Pediatric retinal photograph (wide-field) · 1240x1240 · 100° field of view (Phoenix ICON)
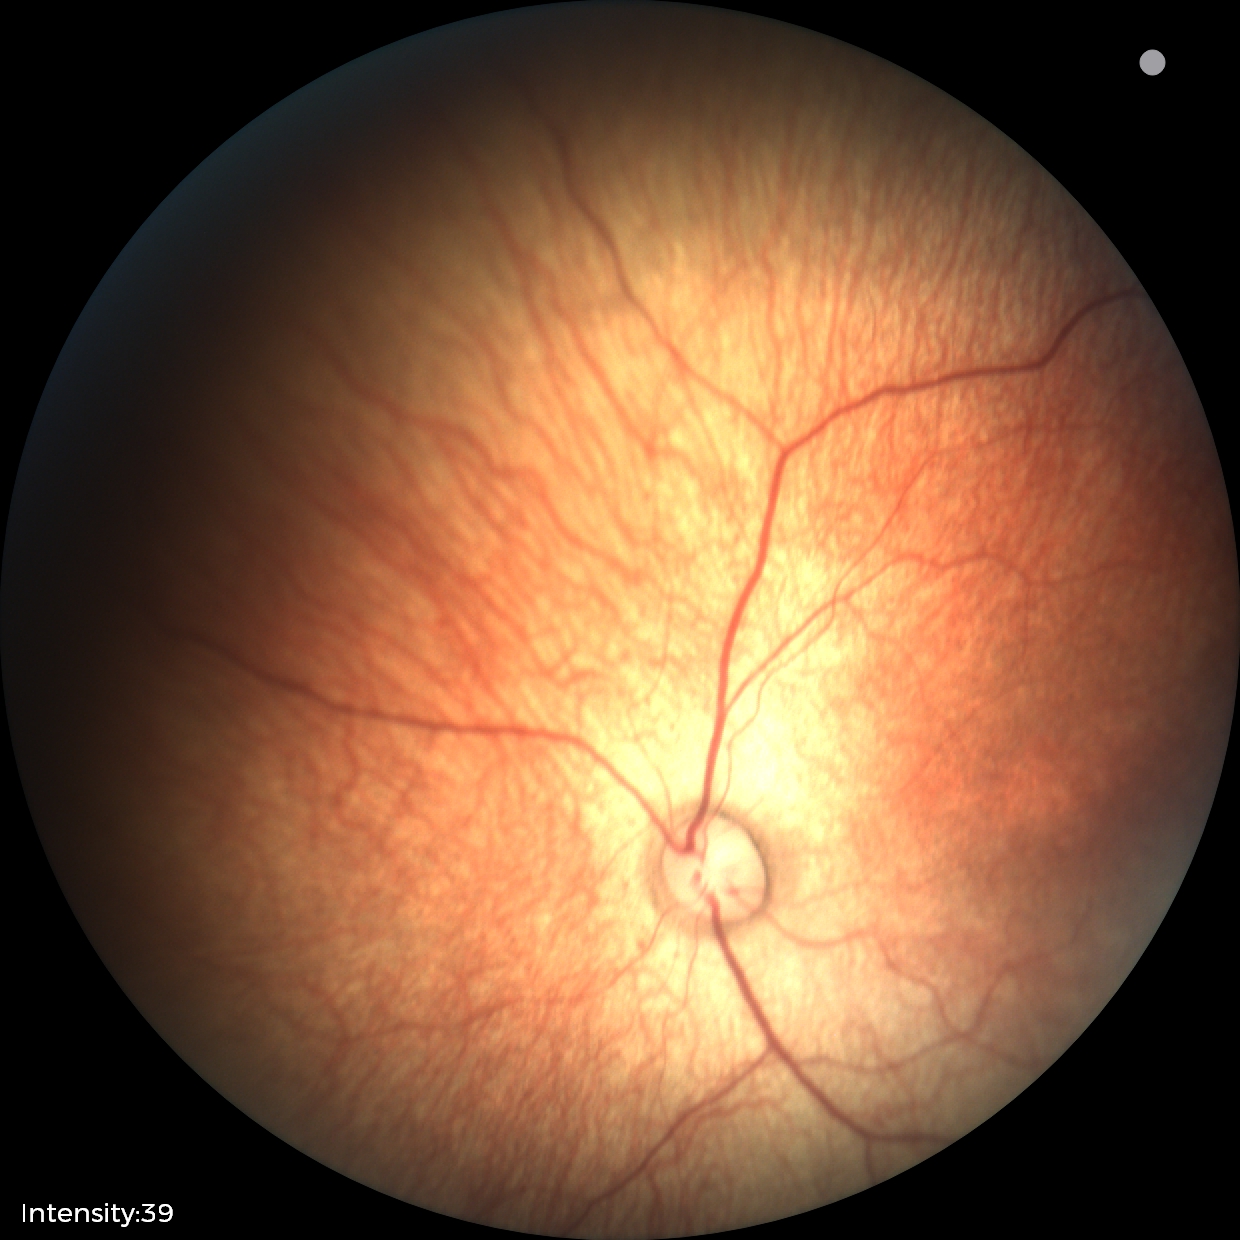
Screening examination diagnosed as physiological.